Pediatric retinal photograph (wide-field): 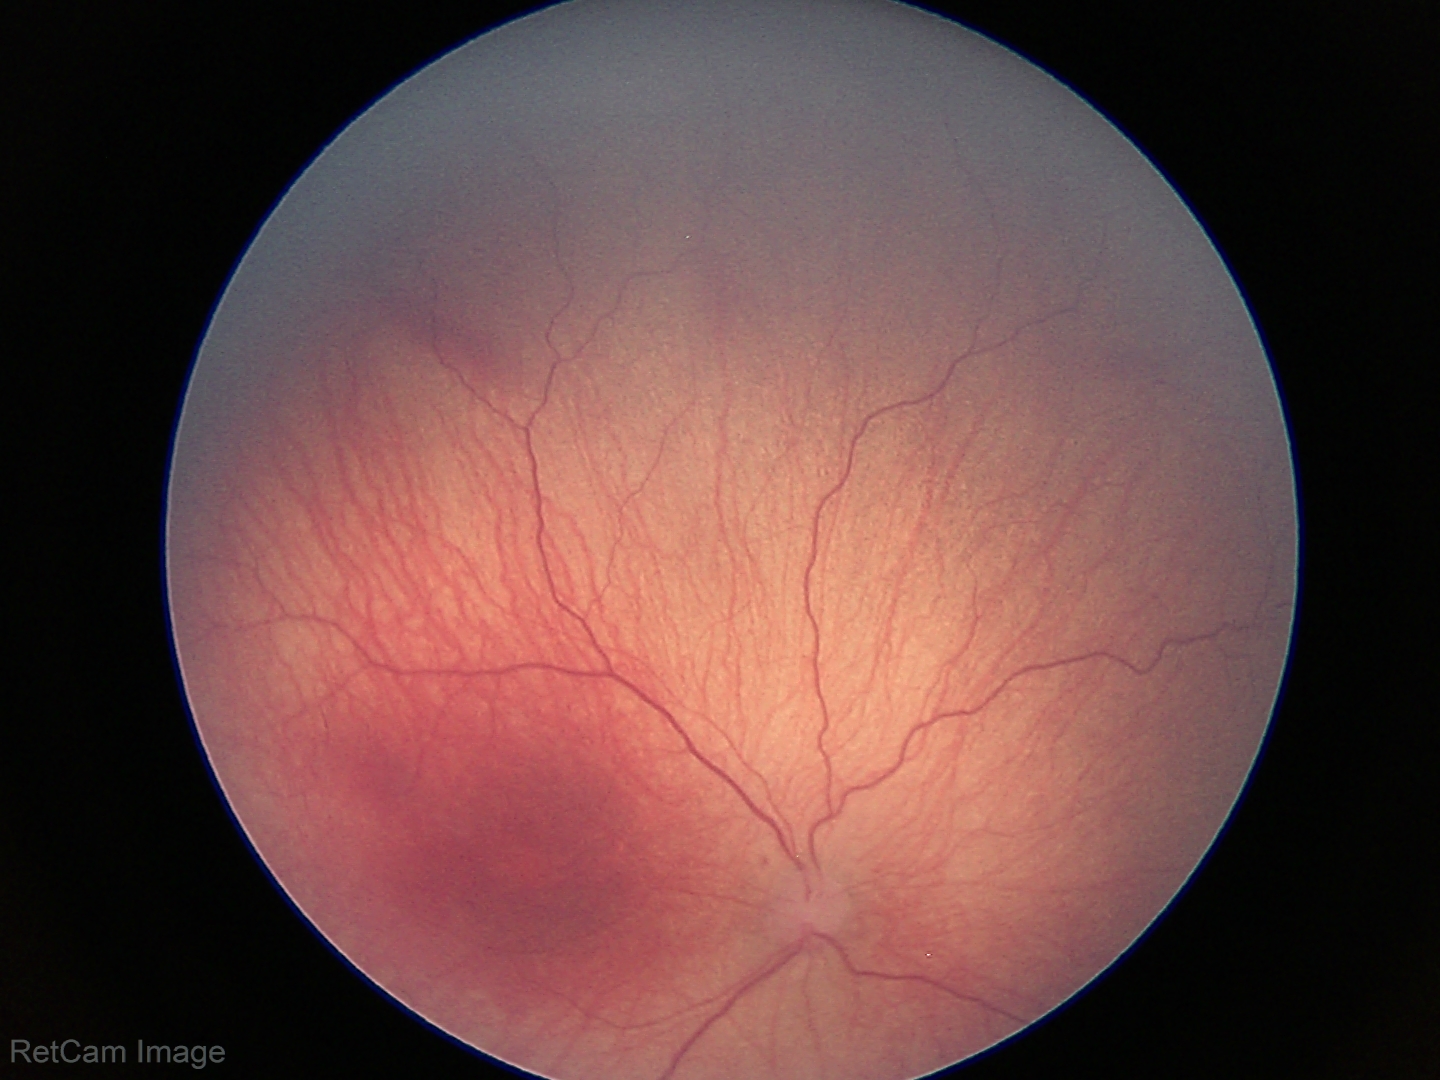 Q: What is the diagnosis from this examination?
A: retinopathy of prematurity (ROP) stage 1
Q: What is the plus-form classification?
A: no plus disease